Without pupil dilation: 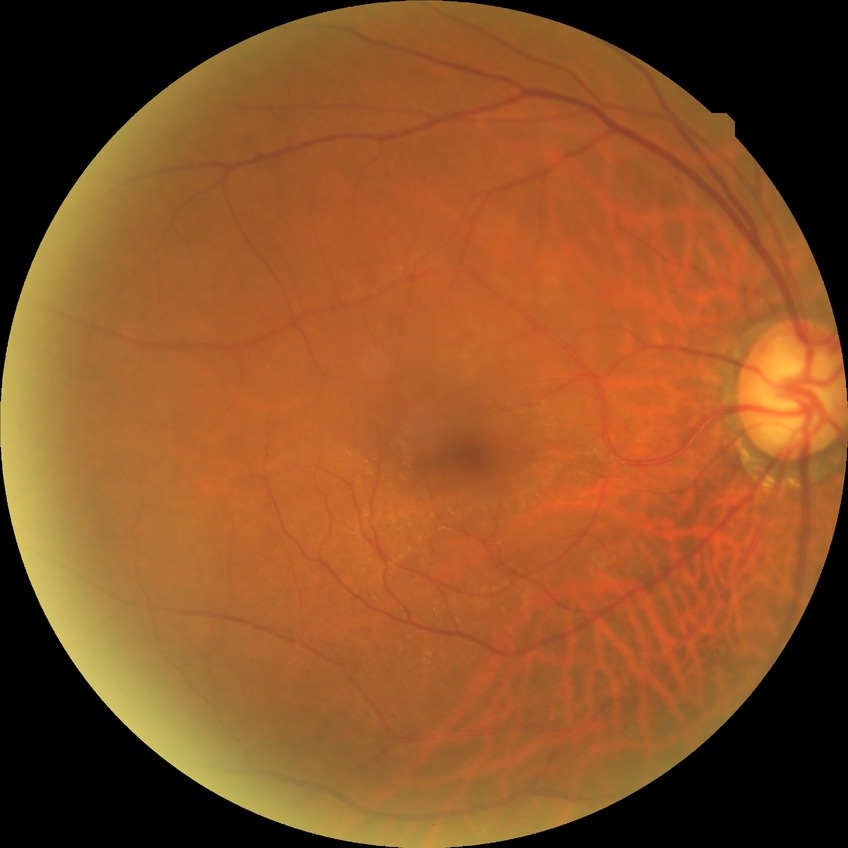

Davis stage is NDR.
No diabetic retinal disease findings.